Camera: Nidek AFC-330 — 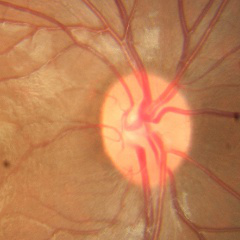
This fundus photograph shows no evidence of glaucoma.